Color fundus photograph — 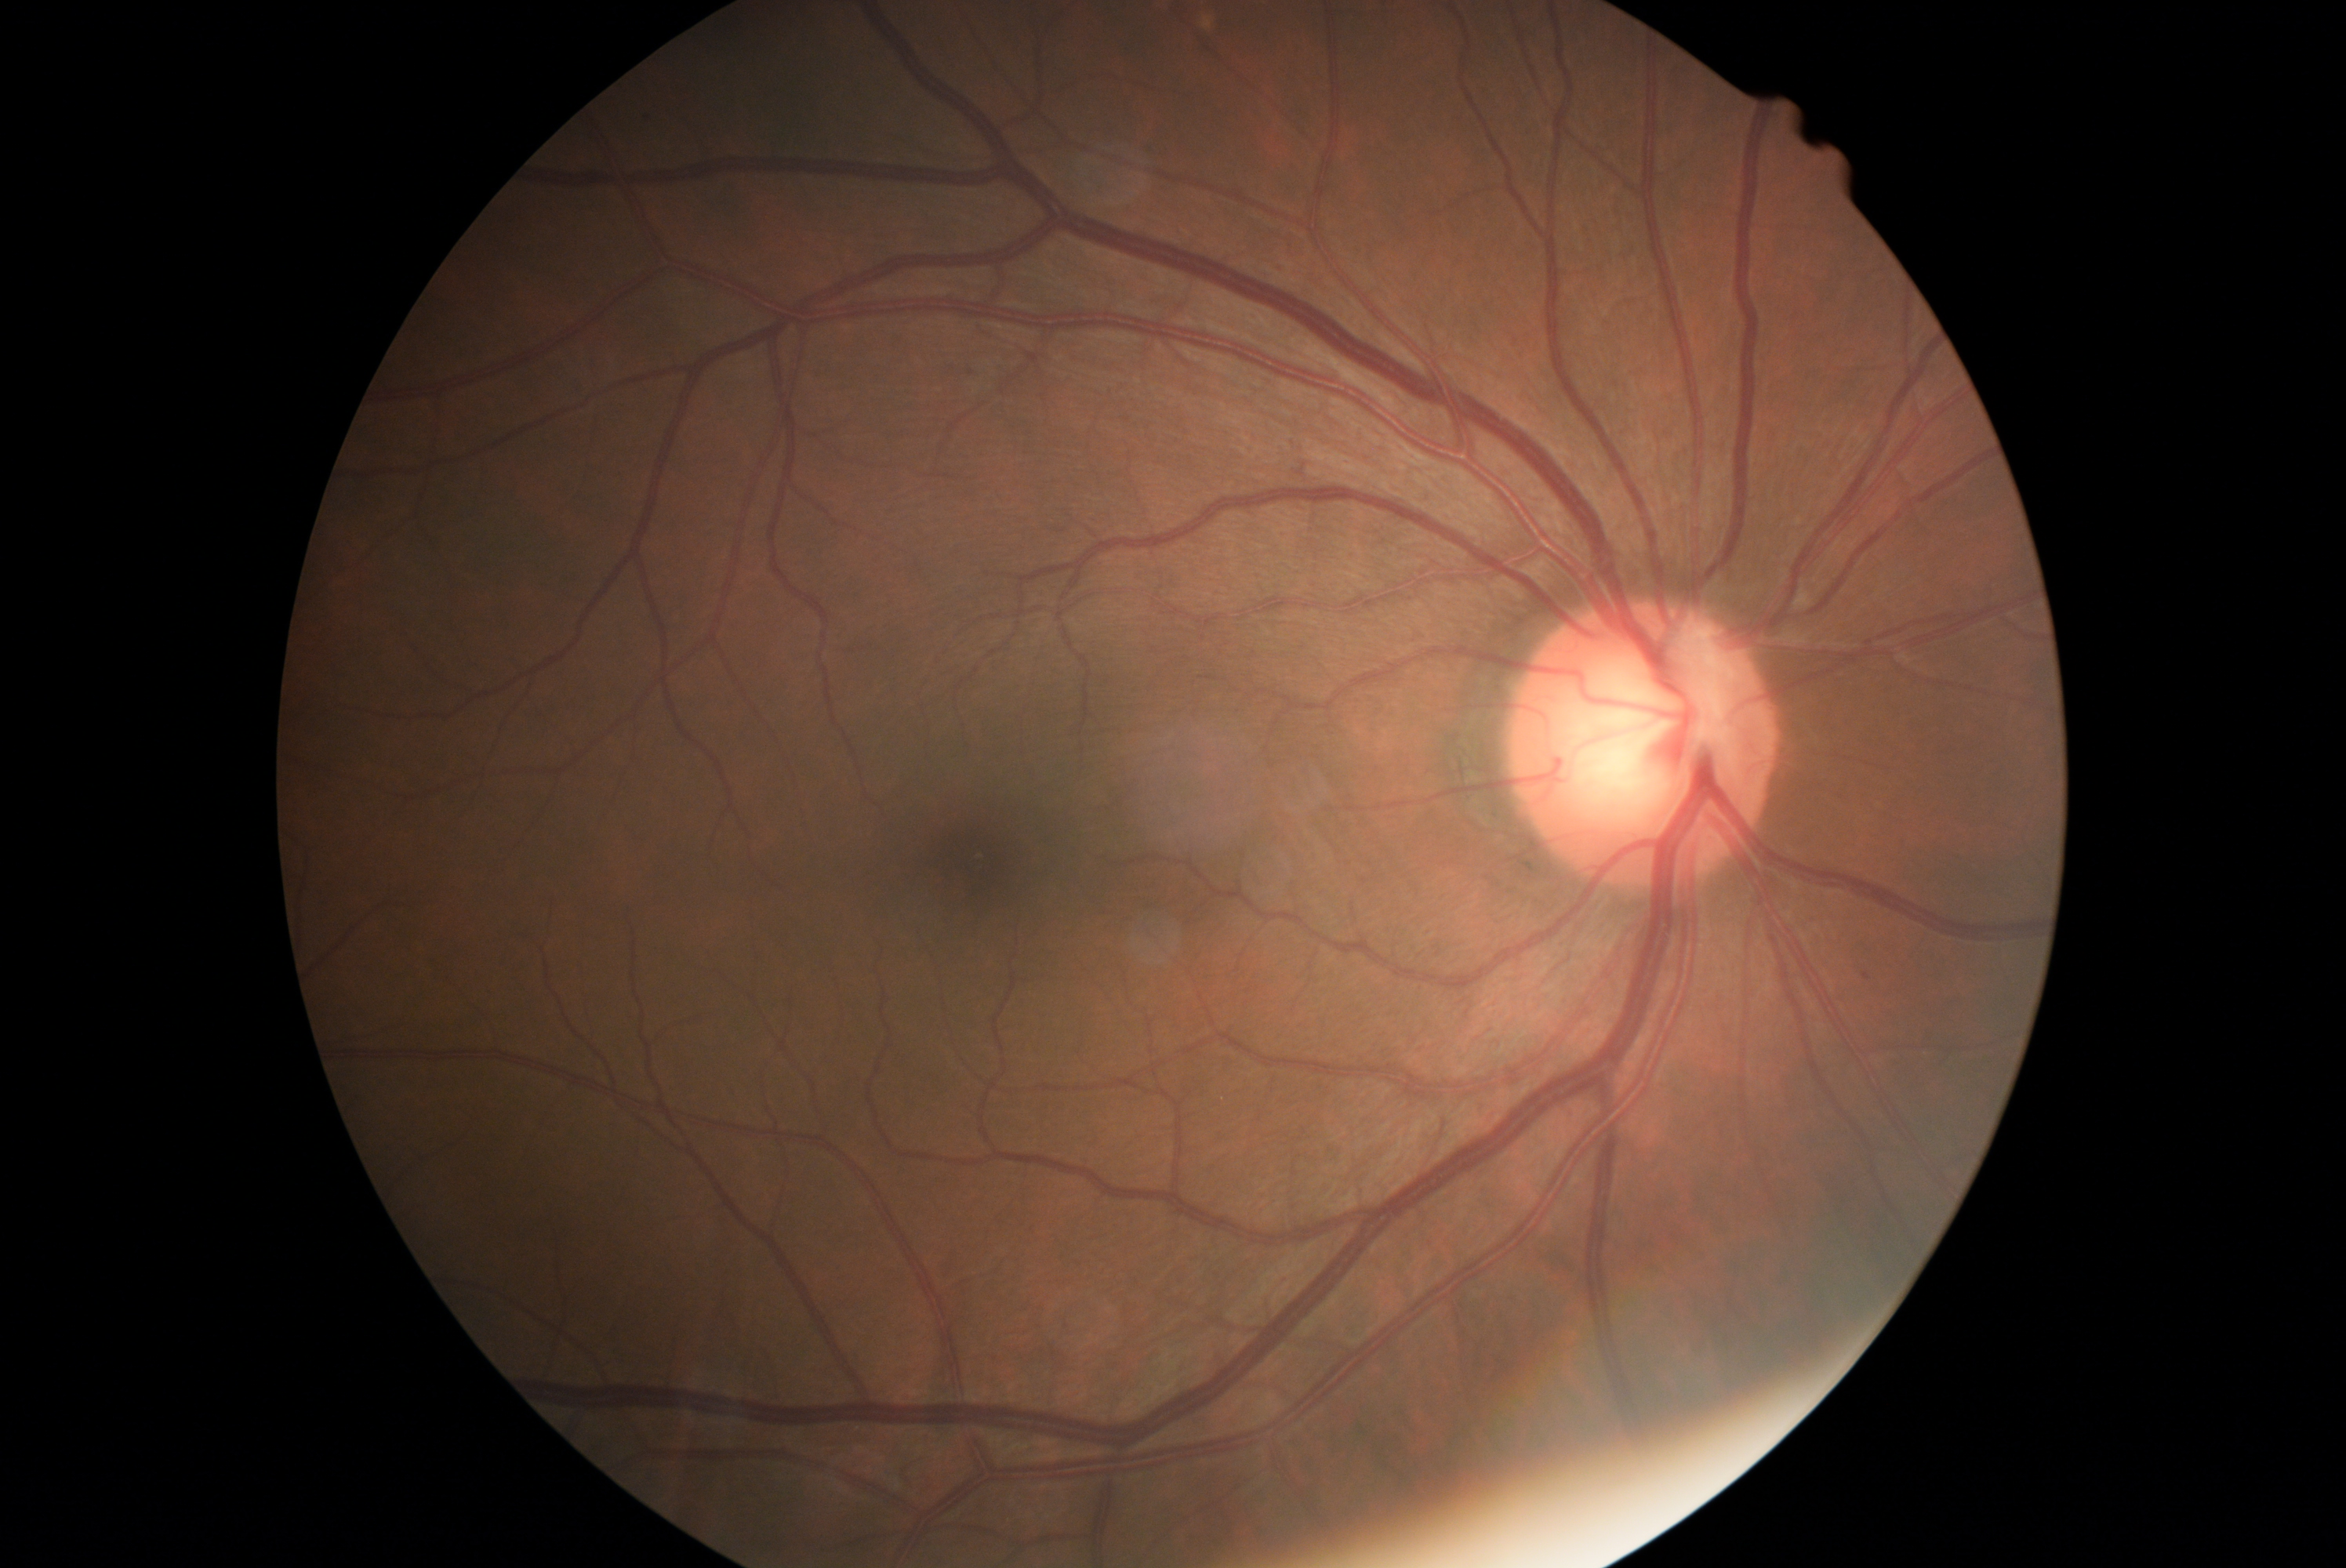

Retinopathy grade is 0/4.